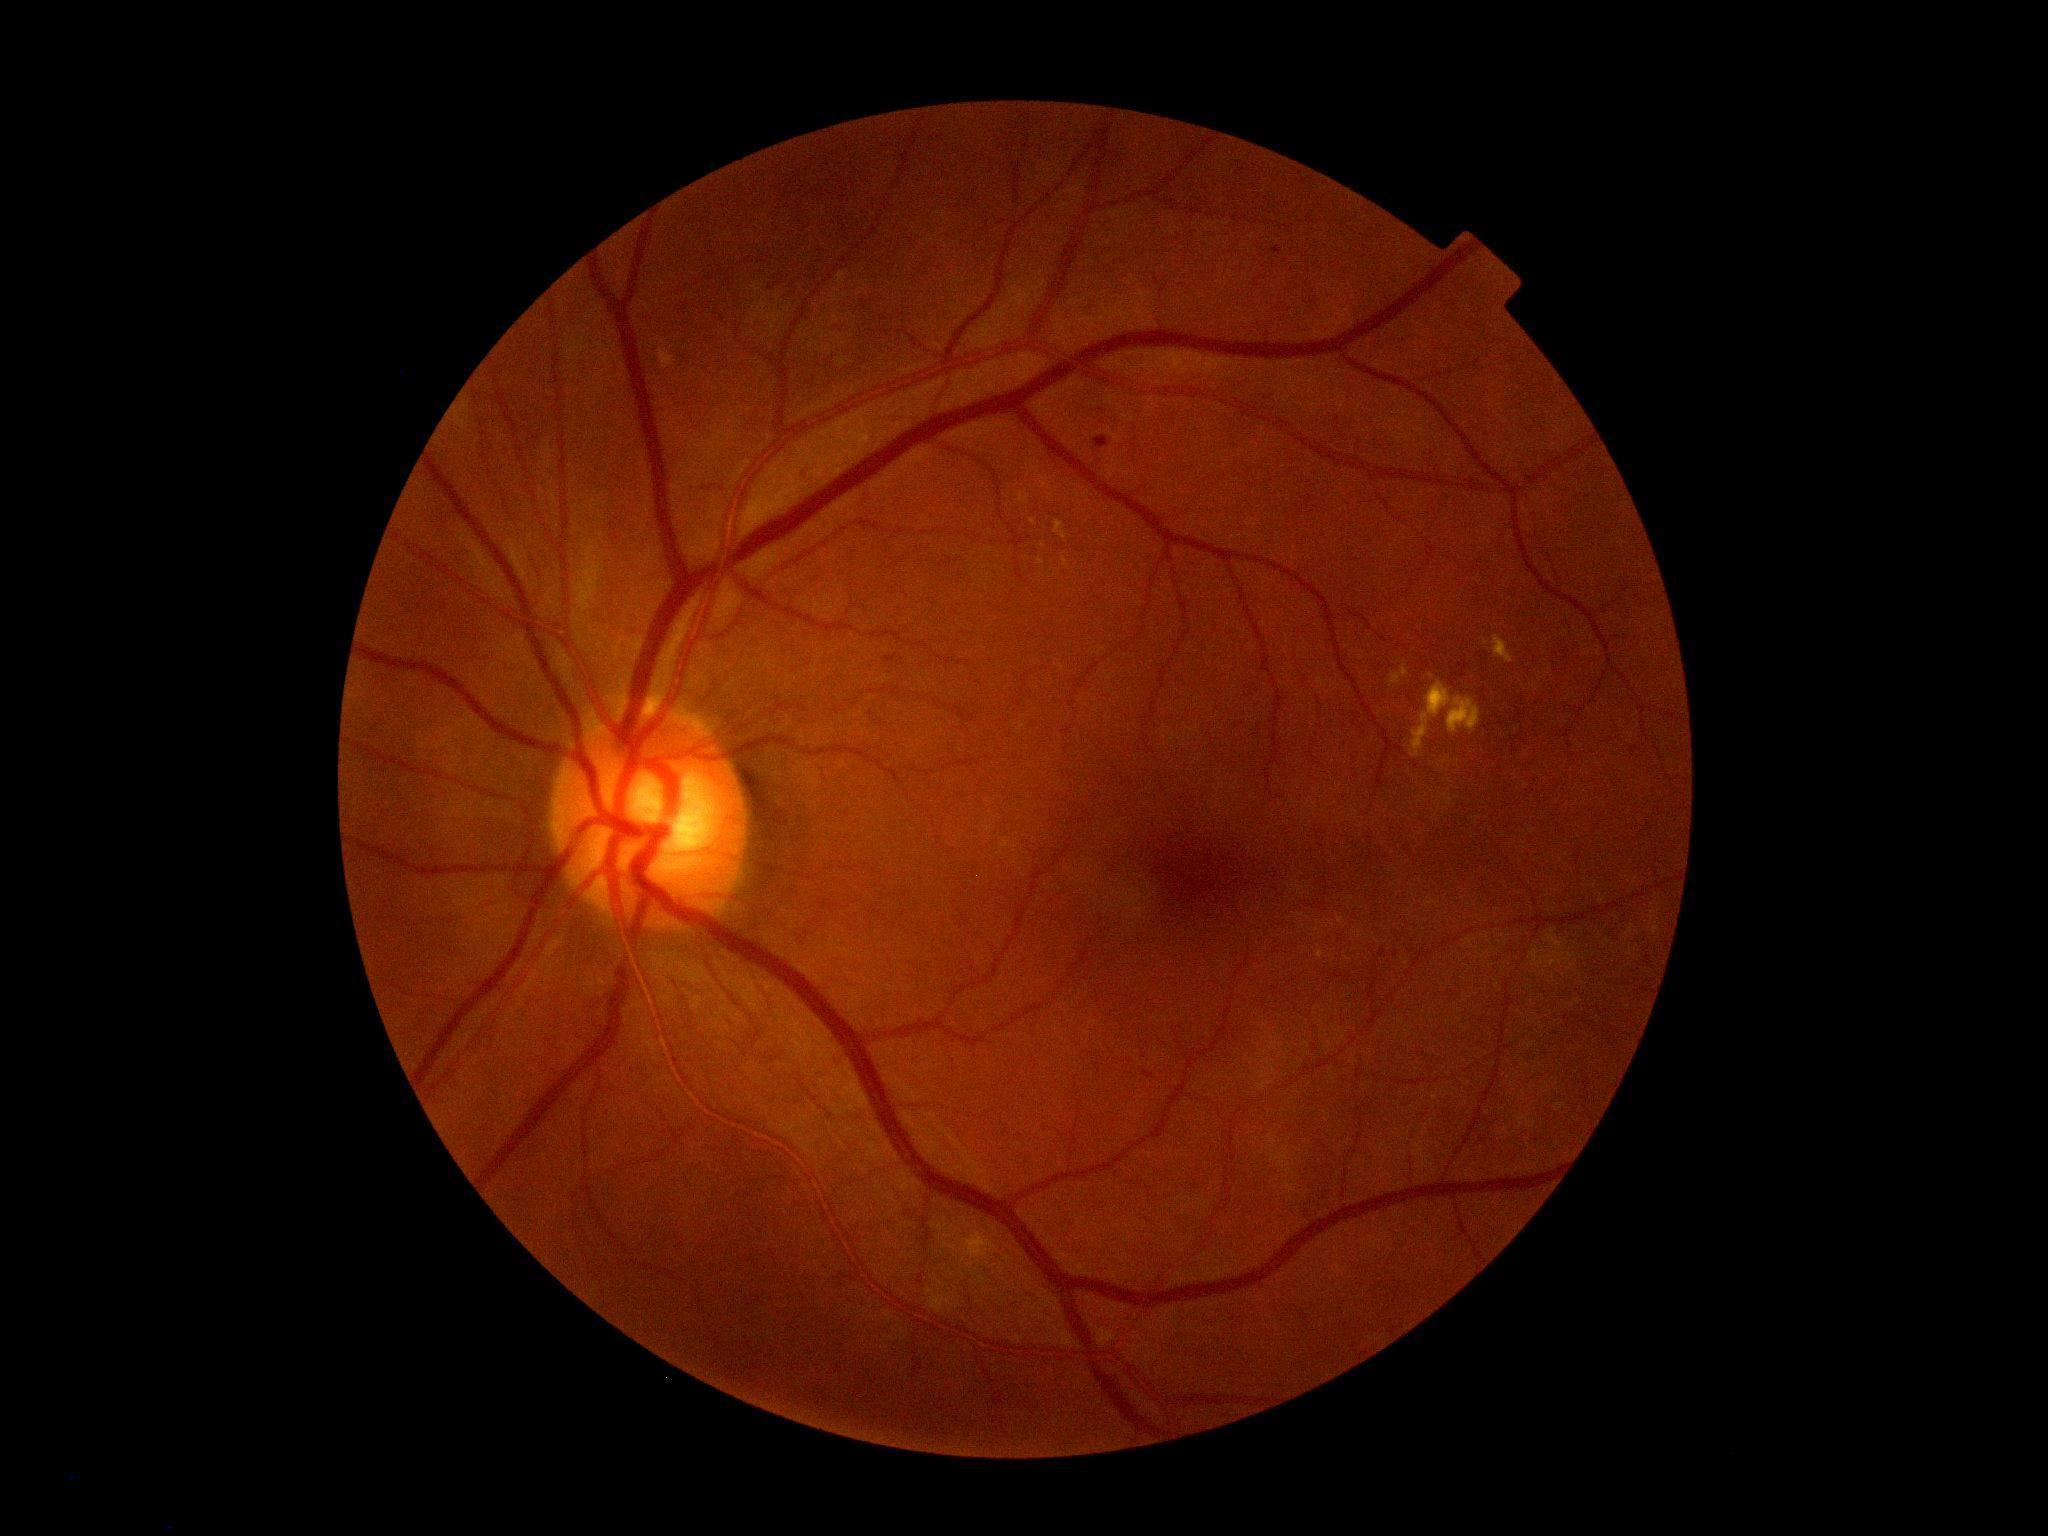
{
  "dr_grade": "2 (moderate NPDR)"
}